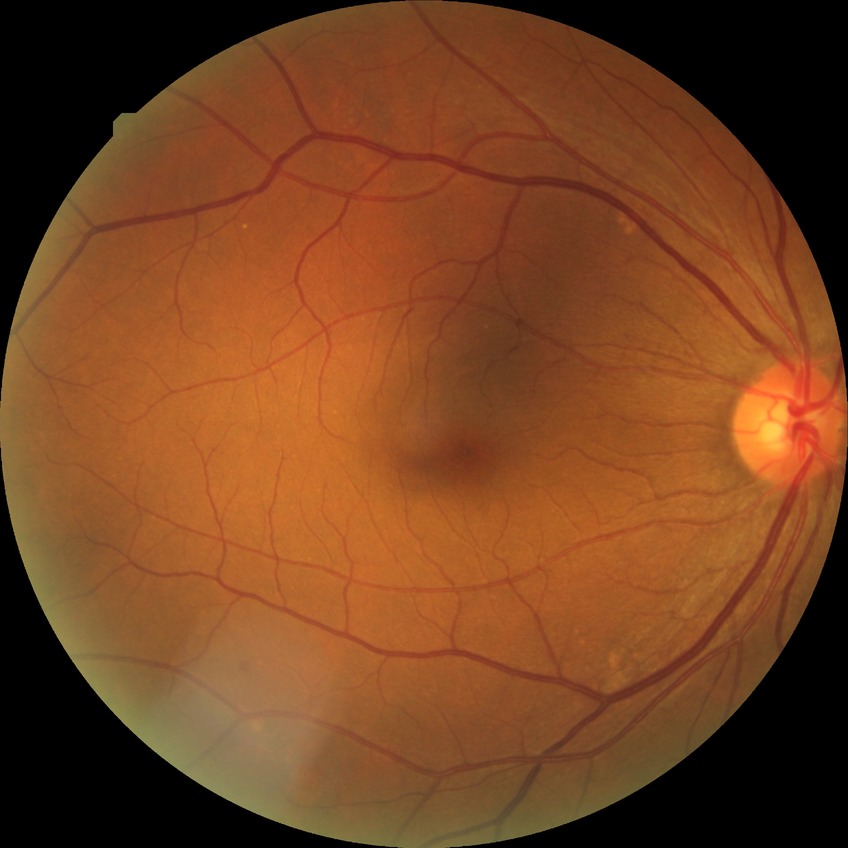 retinopathy grade = simple diabetic retinopathy
DR class = non-proliferative diabetic retinopathy